Retinal fundus photograph; 2352x1568 — 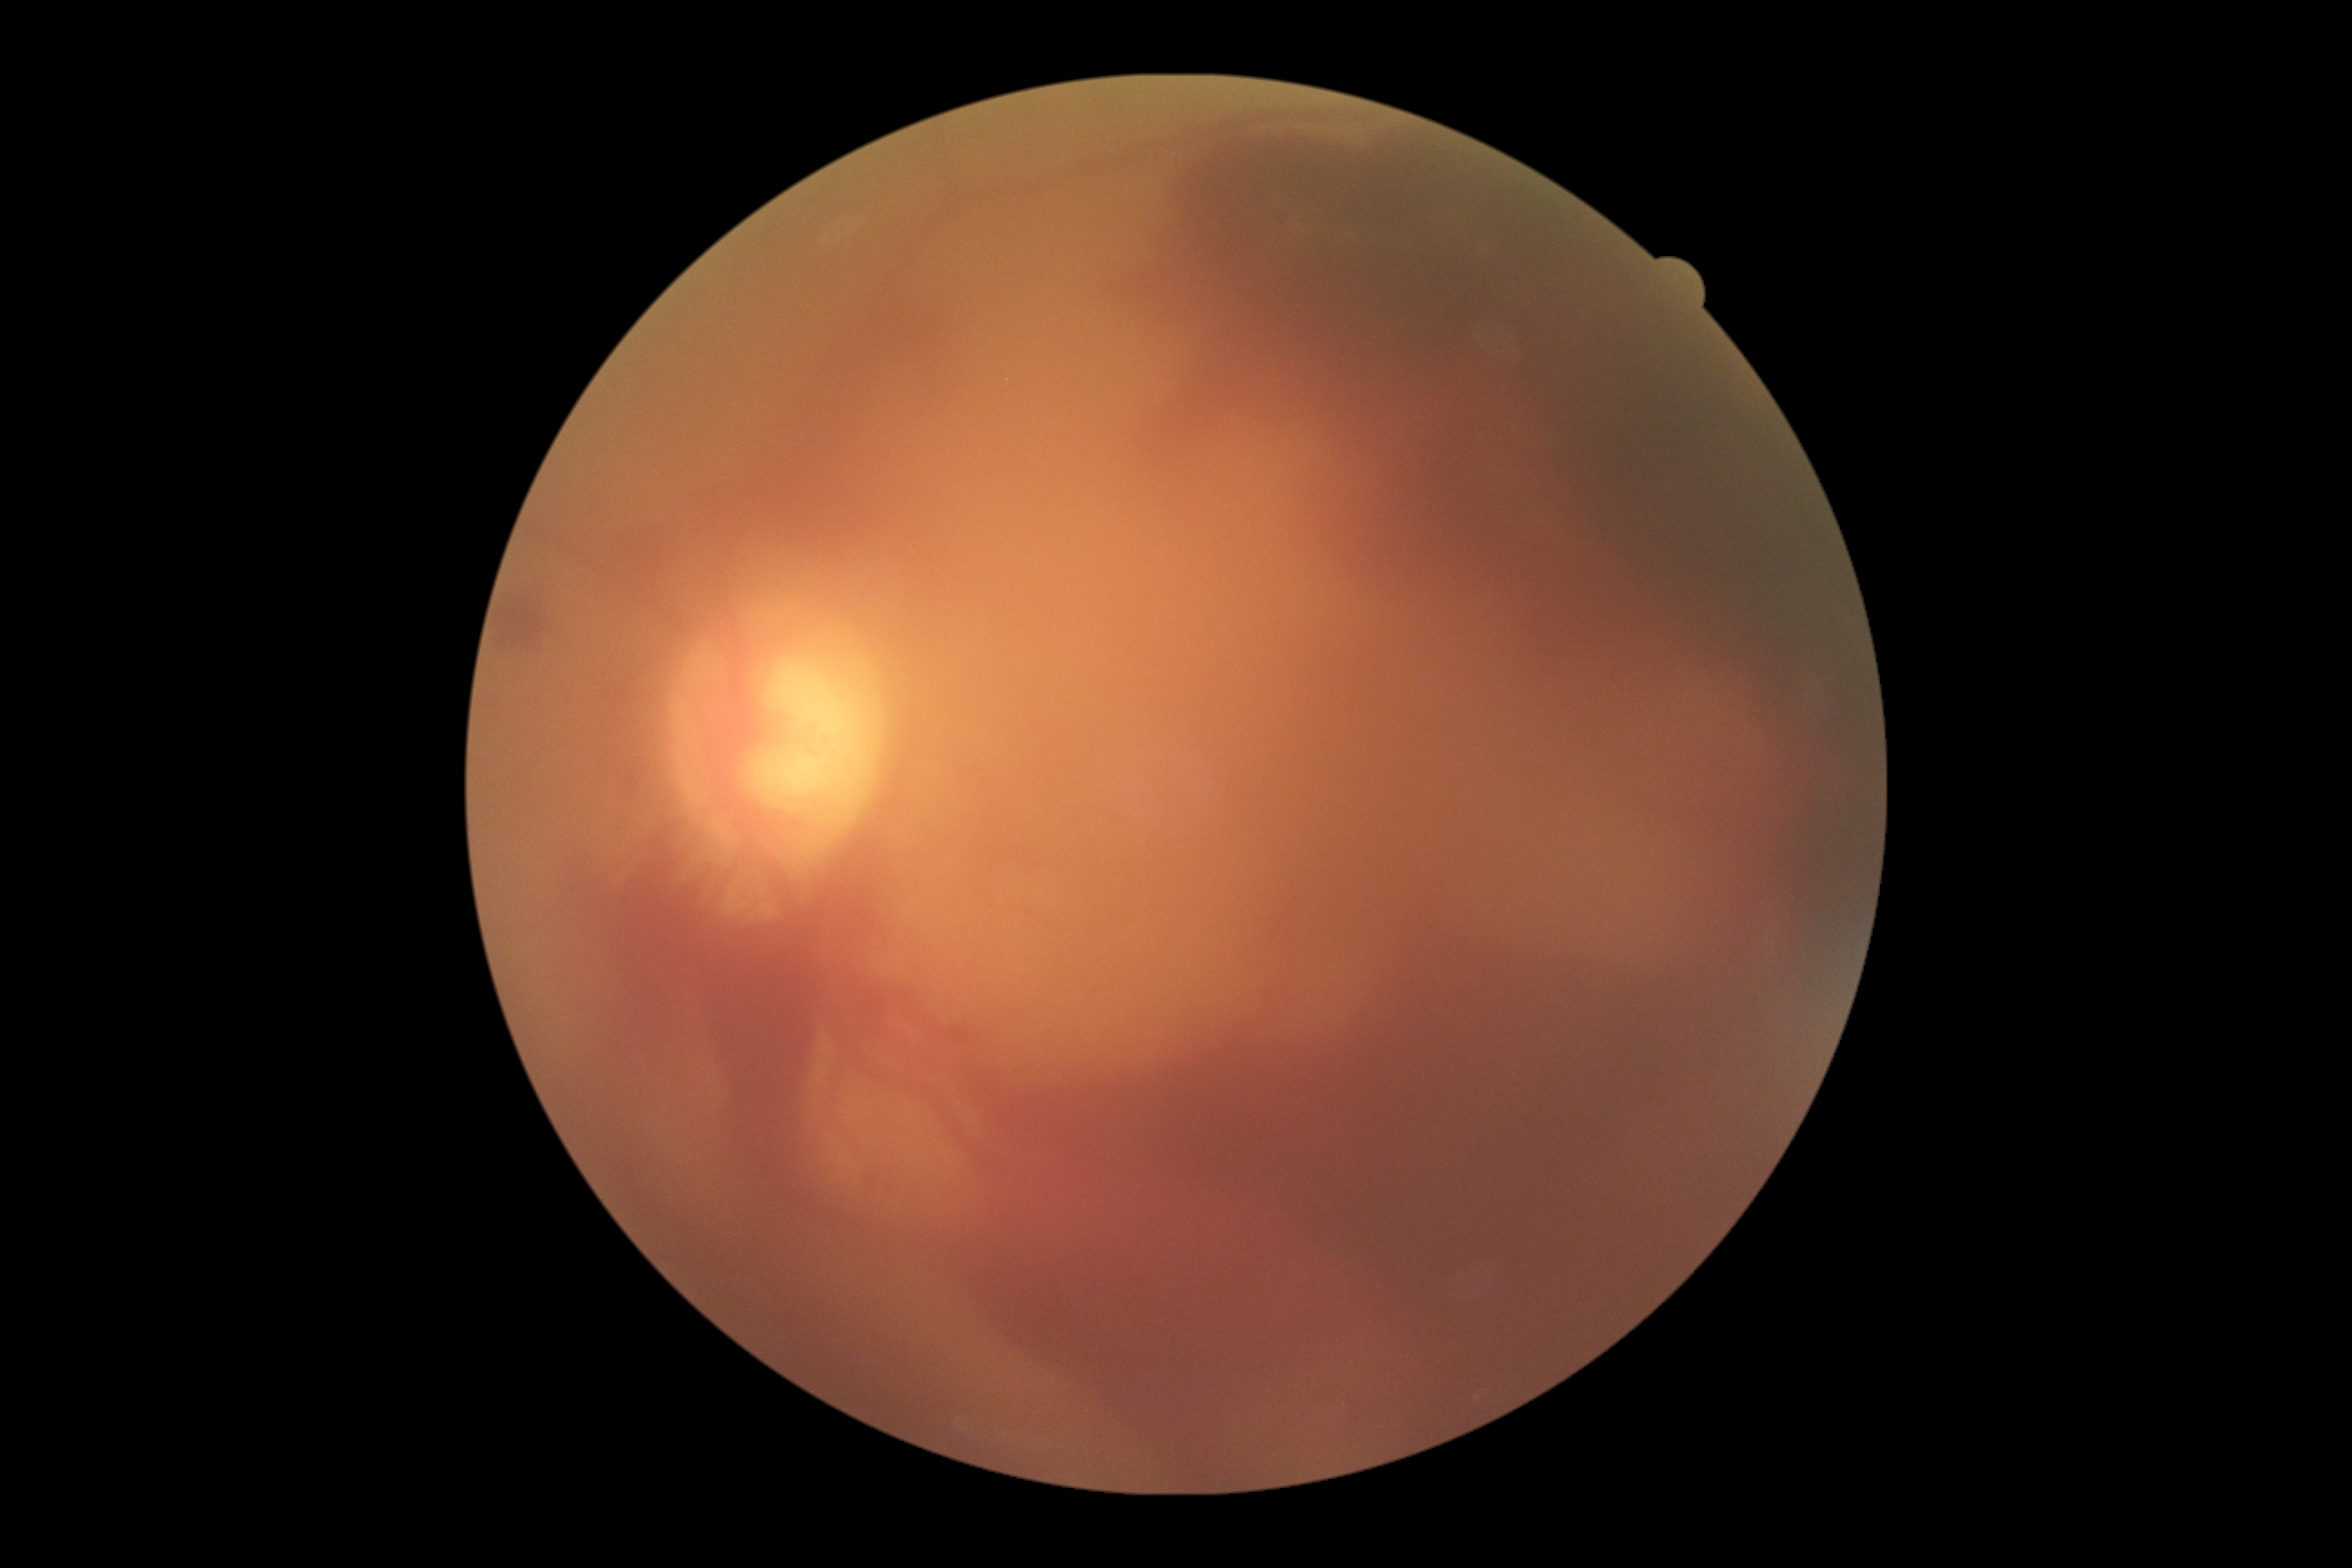 Diabetic retinopathy severity is 4.